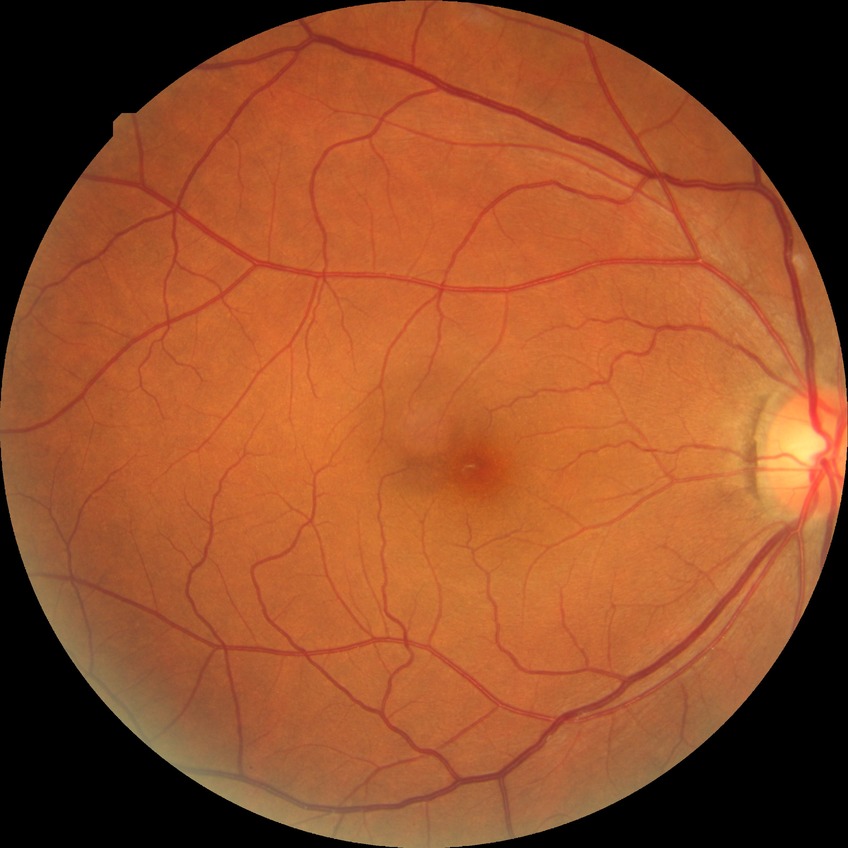
{"davis_grade": "NDR (no diabetic retinopathy)"}